FOV: 45 degrees — 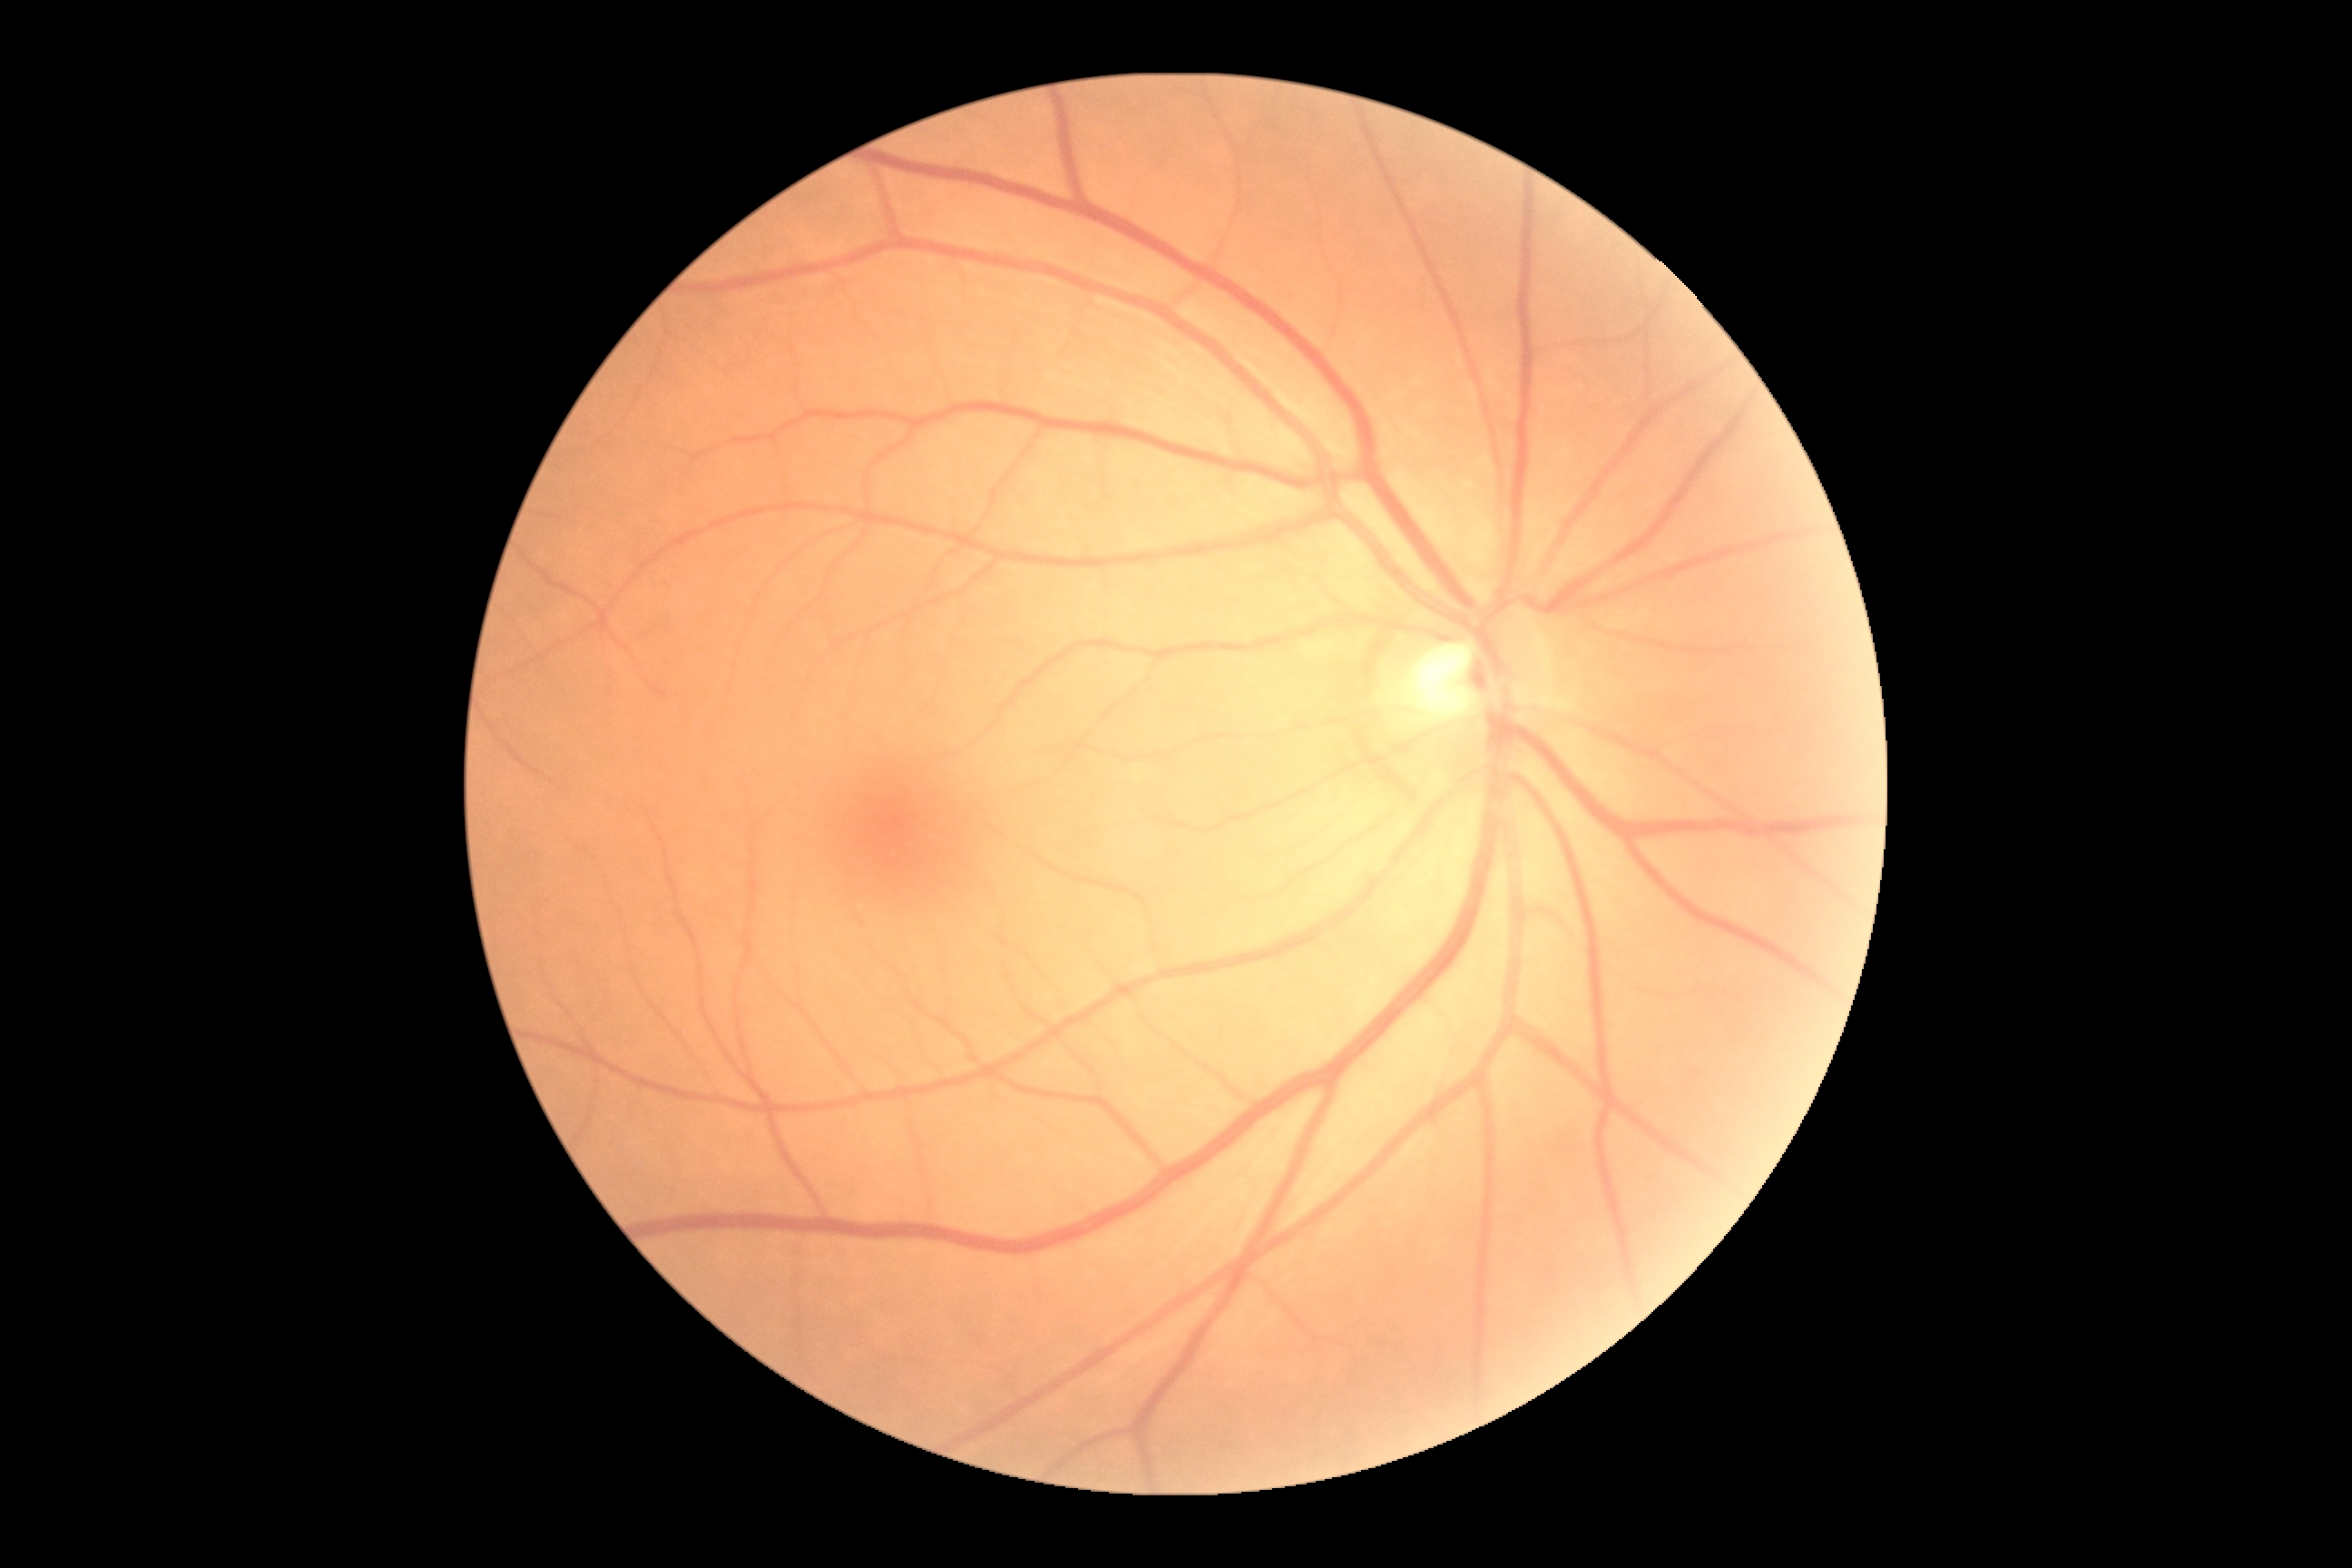 {"dr_grade": "grade 0 (no apparent retinopathy)", "dr_impression": "no signs of DR"}